Remidio Fundus on Phone (FOP) camera. 1659x2212px. Fundus photo — 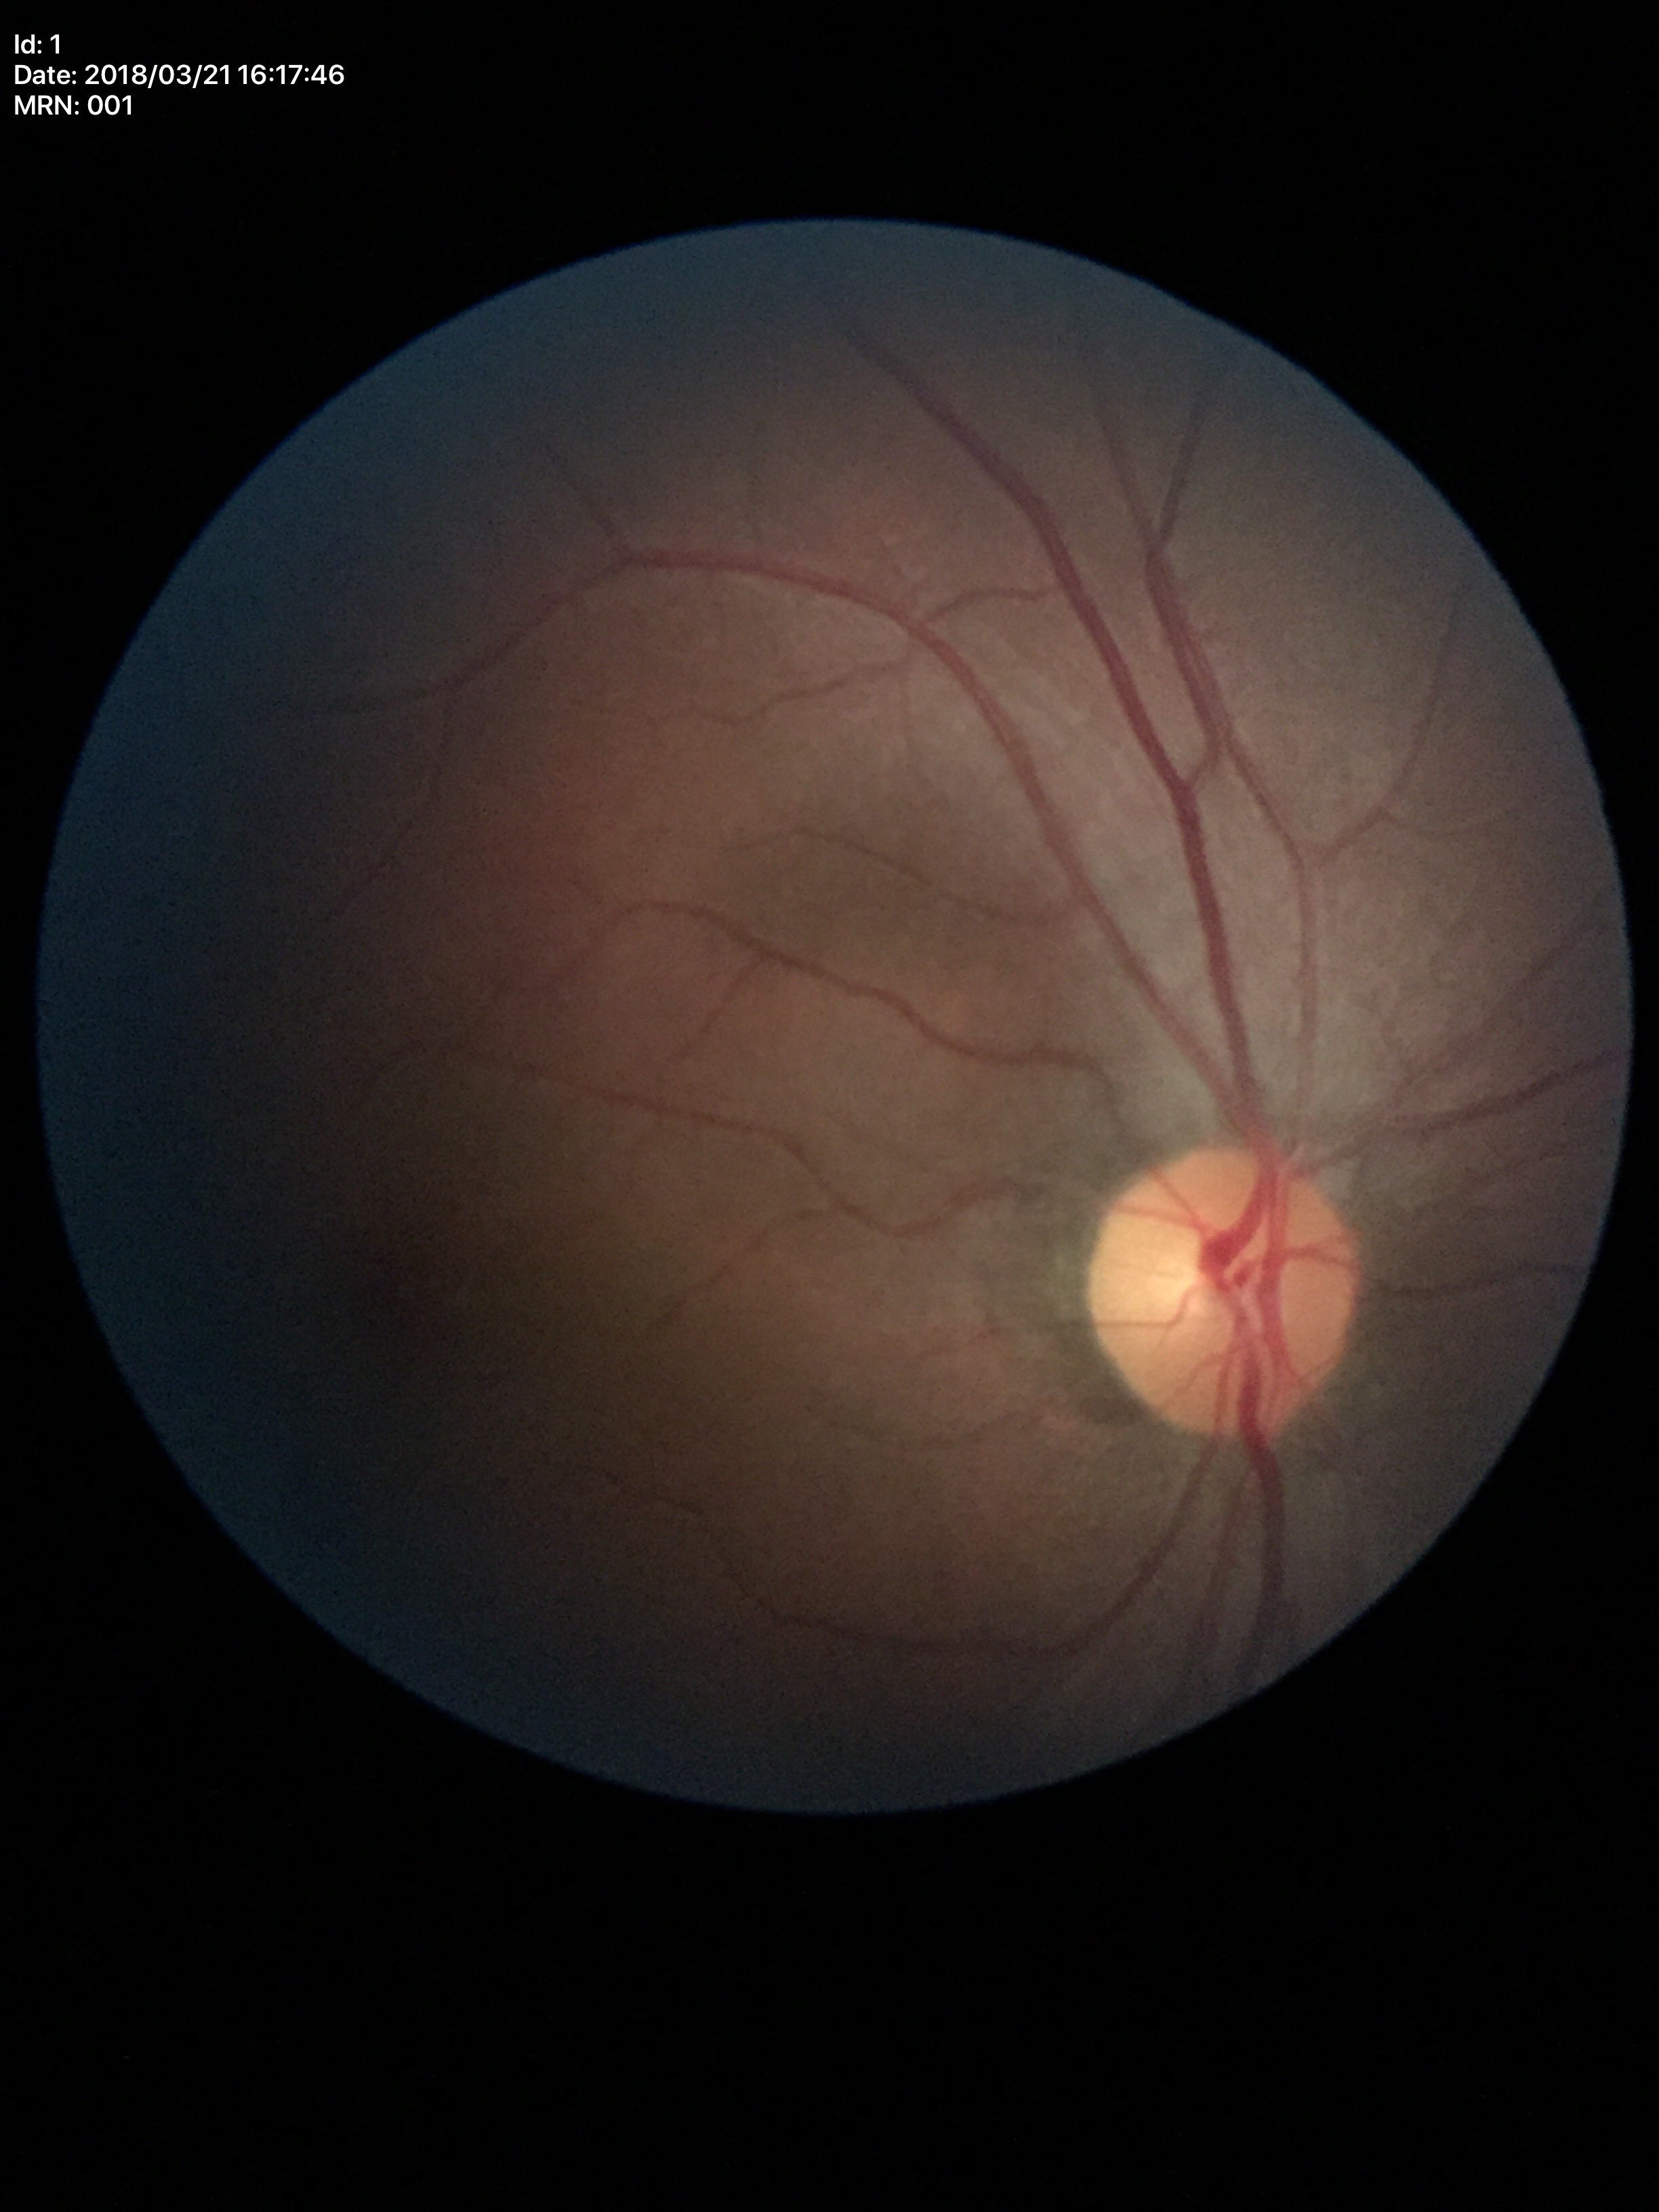
Glaucoma assessment: negative (unanimous normal call).
Vertical cup-to-disc ratio (VCDR) is 0.43.